NIDEK AFC-230, 848 x 848 pixels, nonmydriatic fundus photograph, FOV: 45 degrees
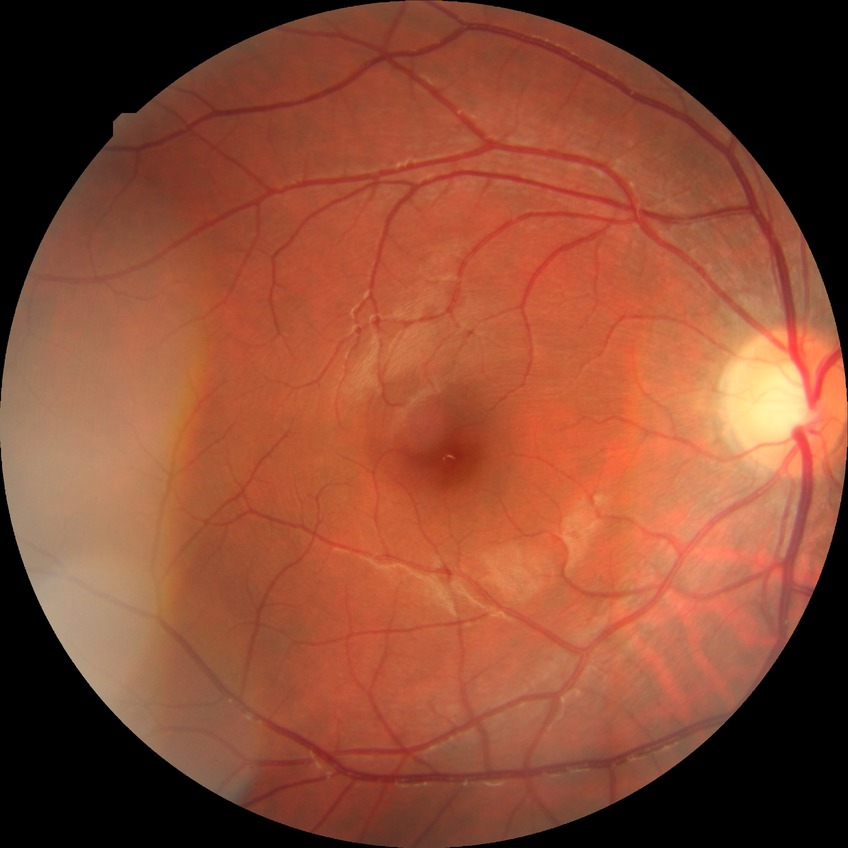

Diabetic retinopathy stage: no diabetic retinopathy.